Image size 2352x1568 · retinal fundus photograph:
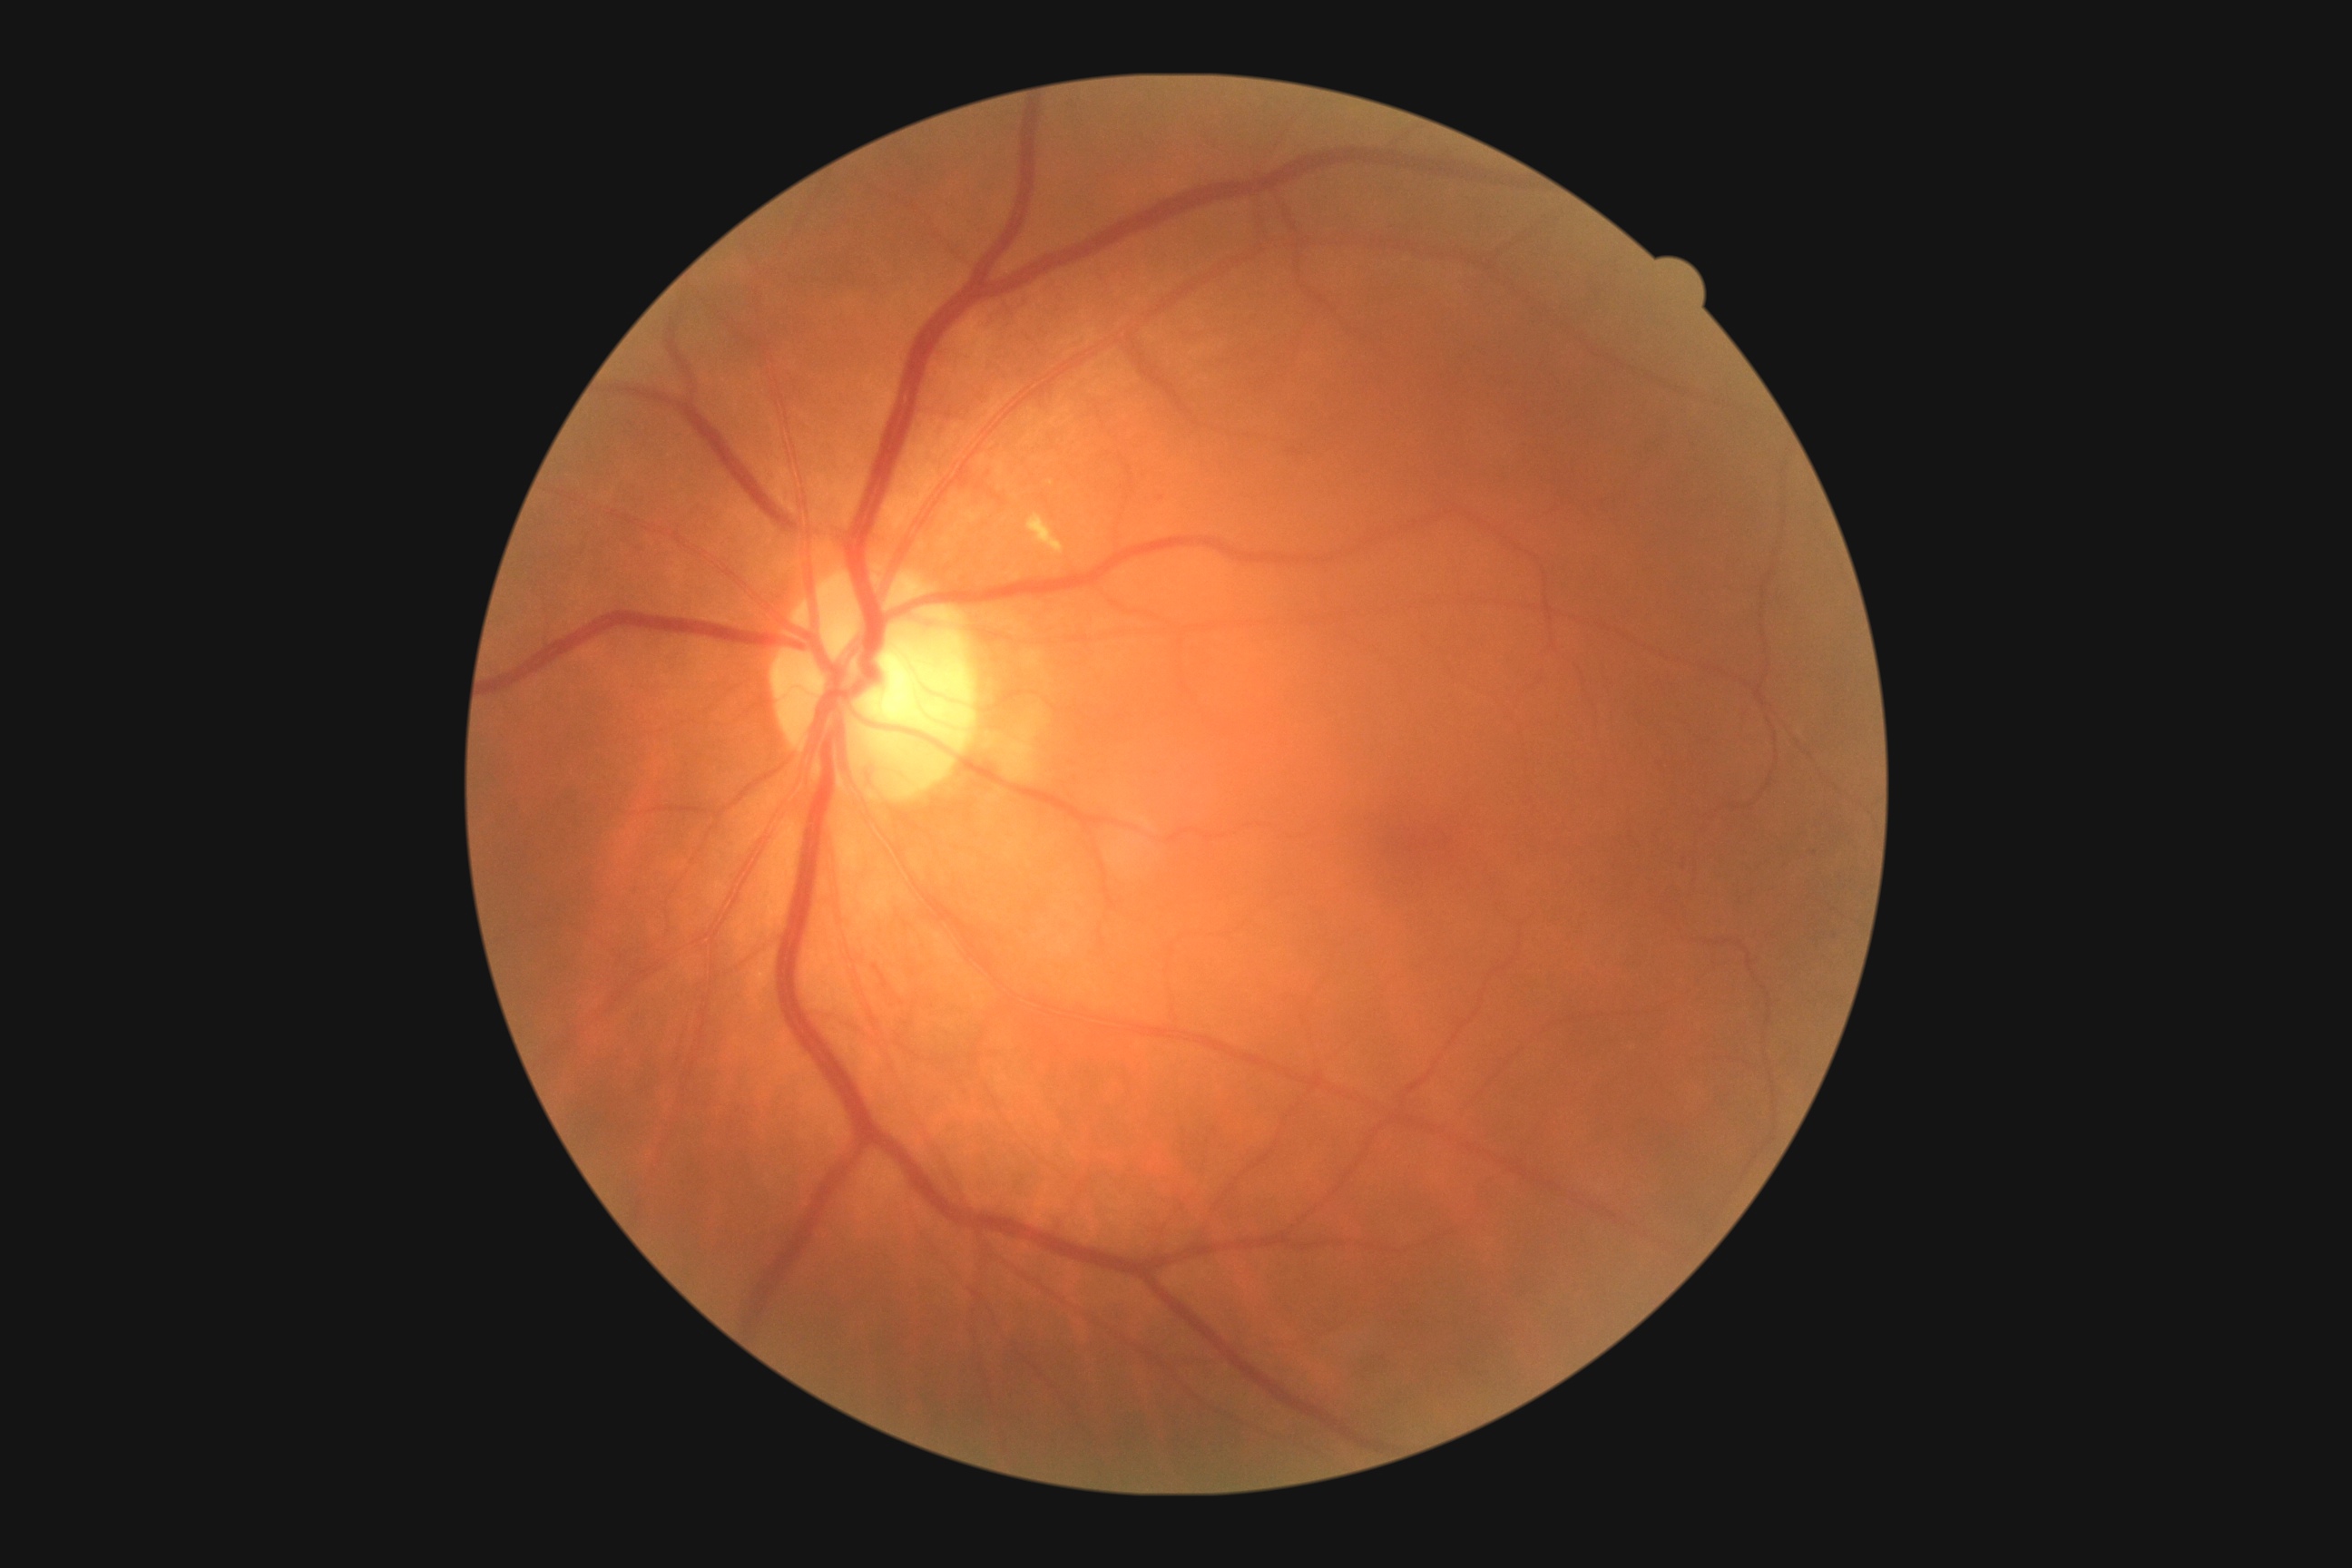

Diabetic retinopathy: grade 2 — more than just microaneurysms but less than severe NPDR.